Graded on the modified Davis scale
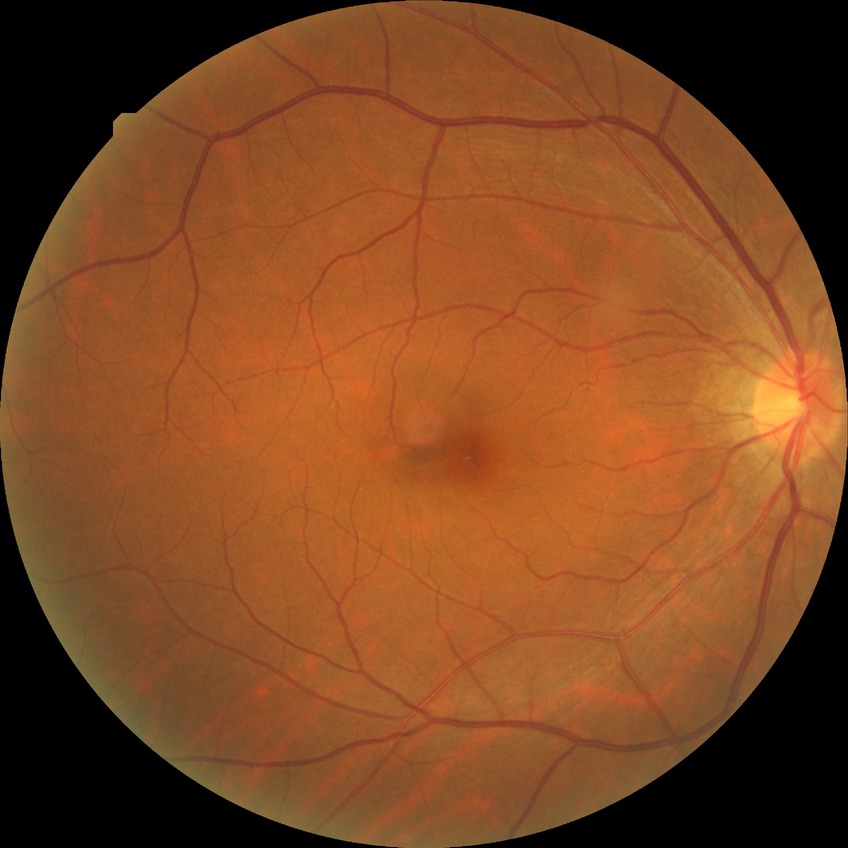
Findings:
* diabetic retinopathy (DR) — no diabetic retinopathy (NDR)